DR severity per modified Davis staging — 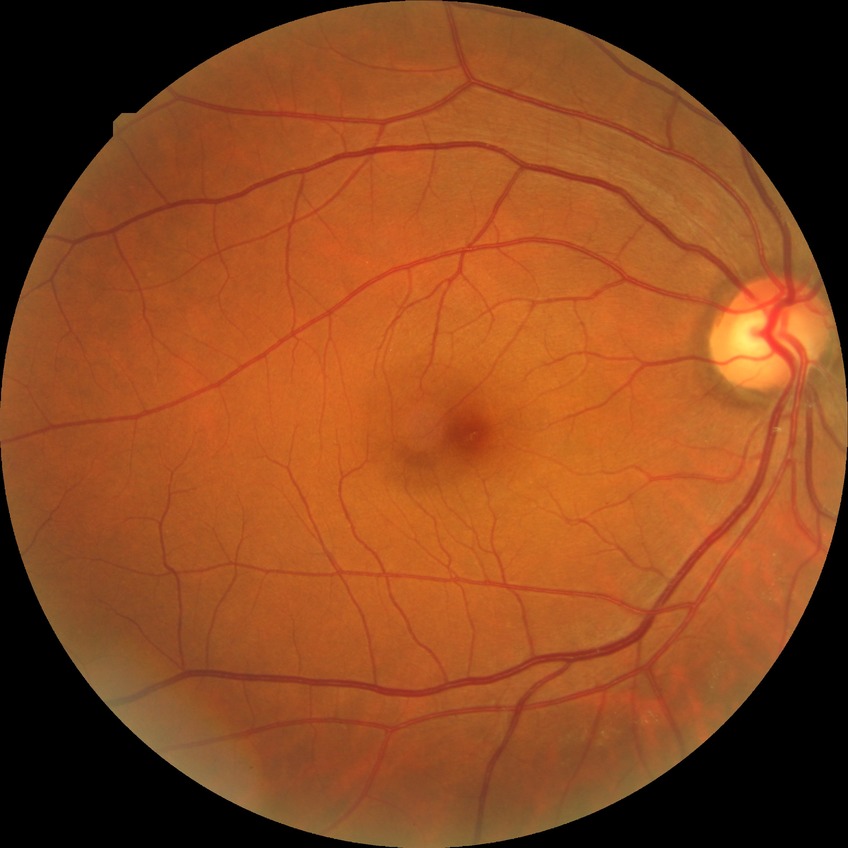
Modified Davis grading is no diabetic retinopathy.